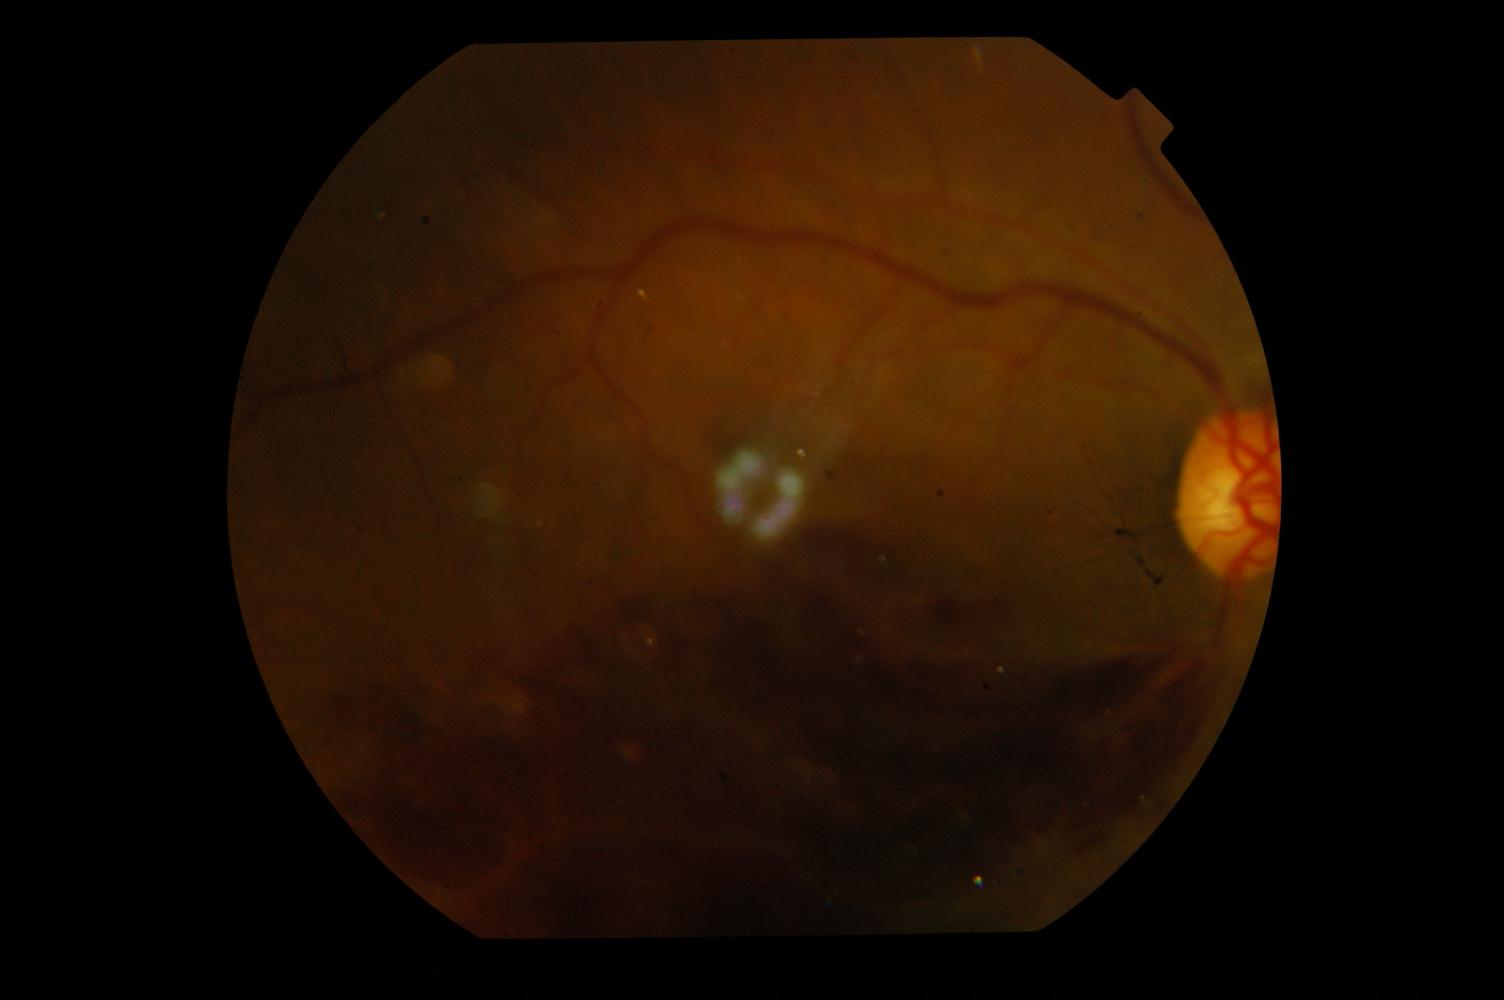 Fundus image with findings of branch retinal vein occlusion.